45° field of view. CFP. Modified Davis classification: 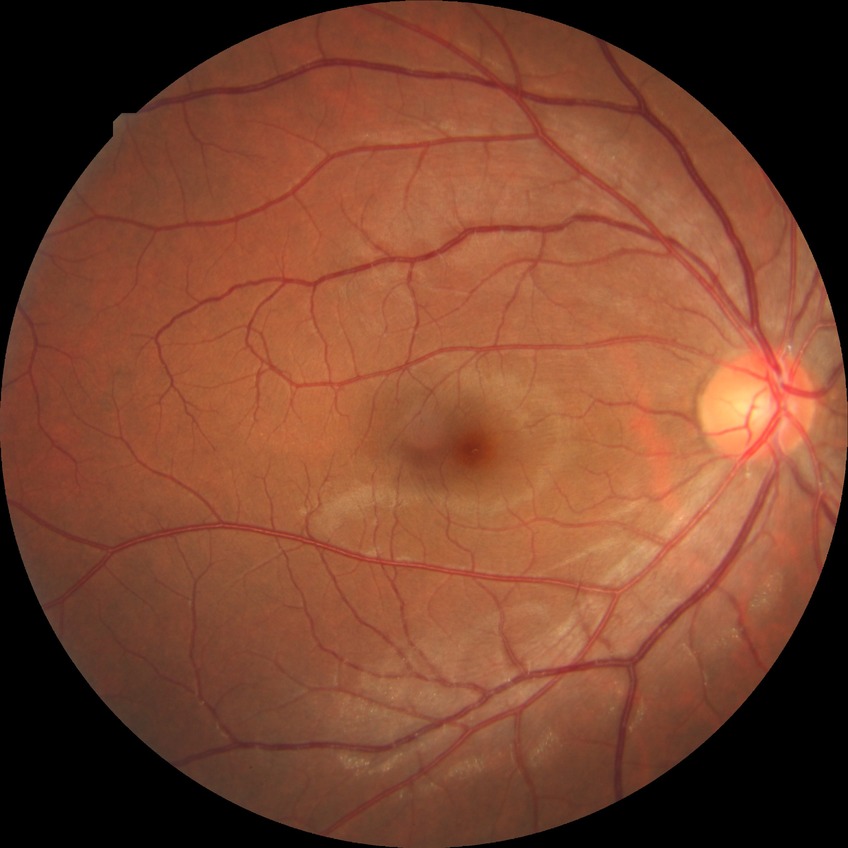 Davis grade: NDR.